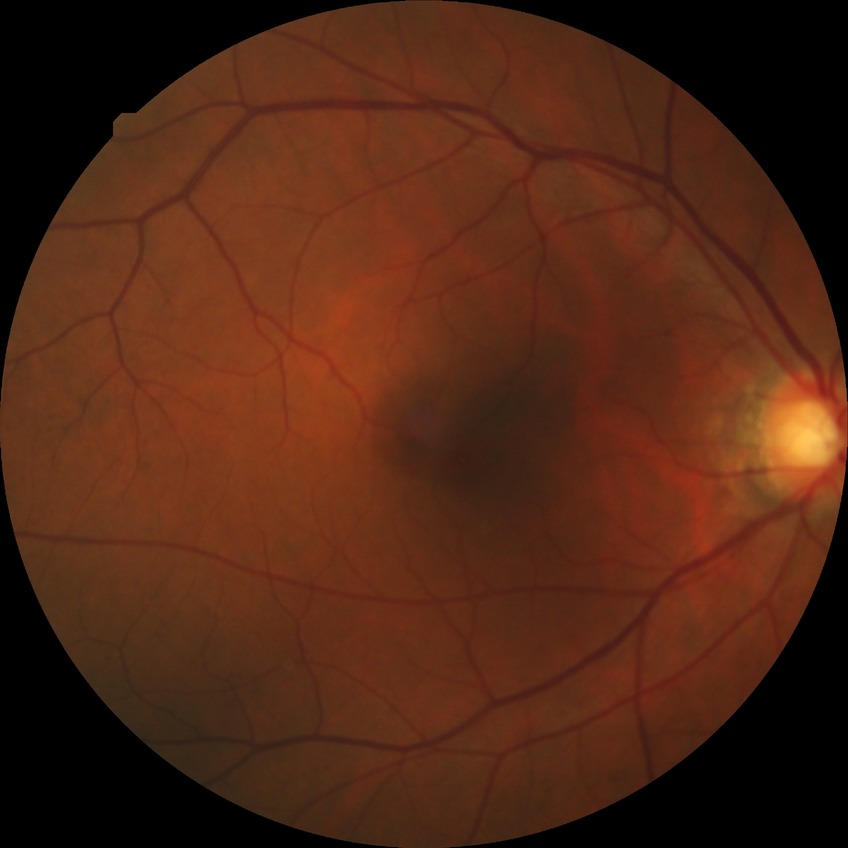
Diabetic retinopathy (DR) is no diabetic retinopathy (NDR).